Infant wide-field fundus photograph:
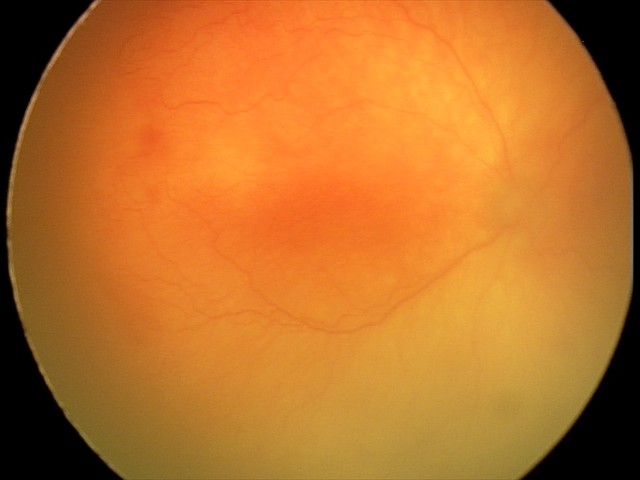
Screening: aggressive retinopathy of prematurity.